Wide-field fundus photograph from neonatal ROP screening
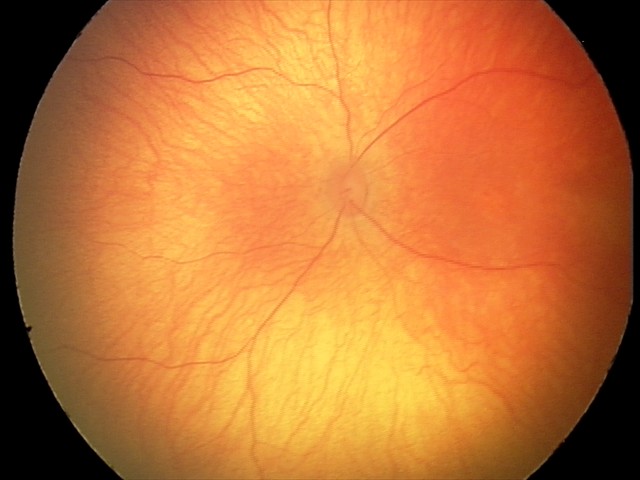
No retinal pathology identified on screening.